45° field of view — 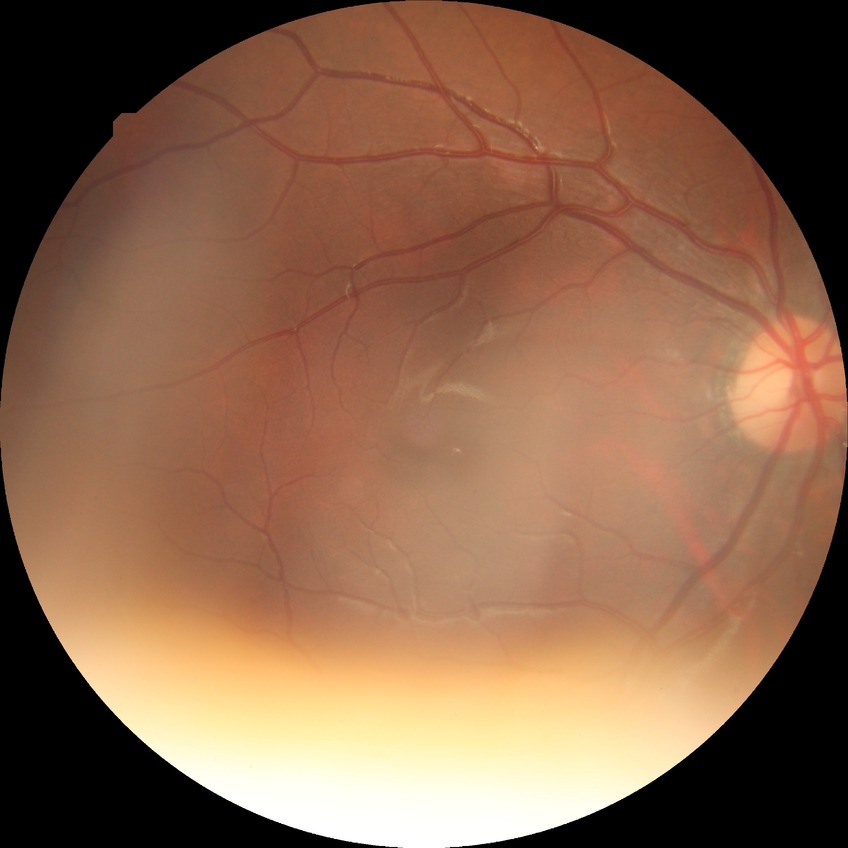
Diabetic retinopathy (DR): no diabetic retinopathy (NDR).